Acquired with a Remidio FOP fundus camera. 1659 x 2212 pixels: 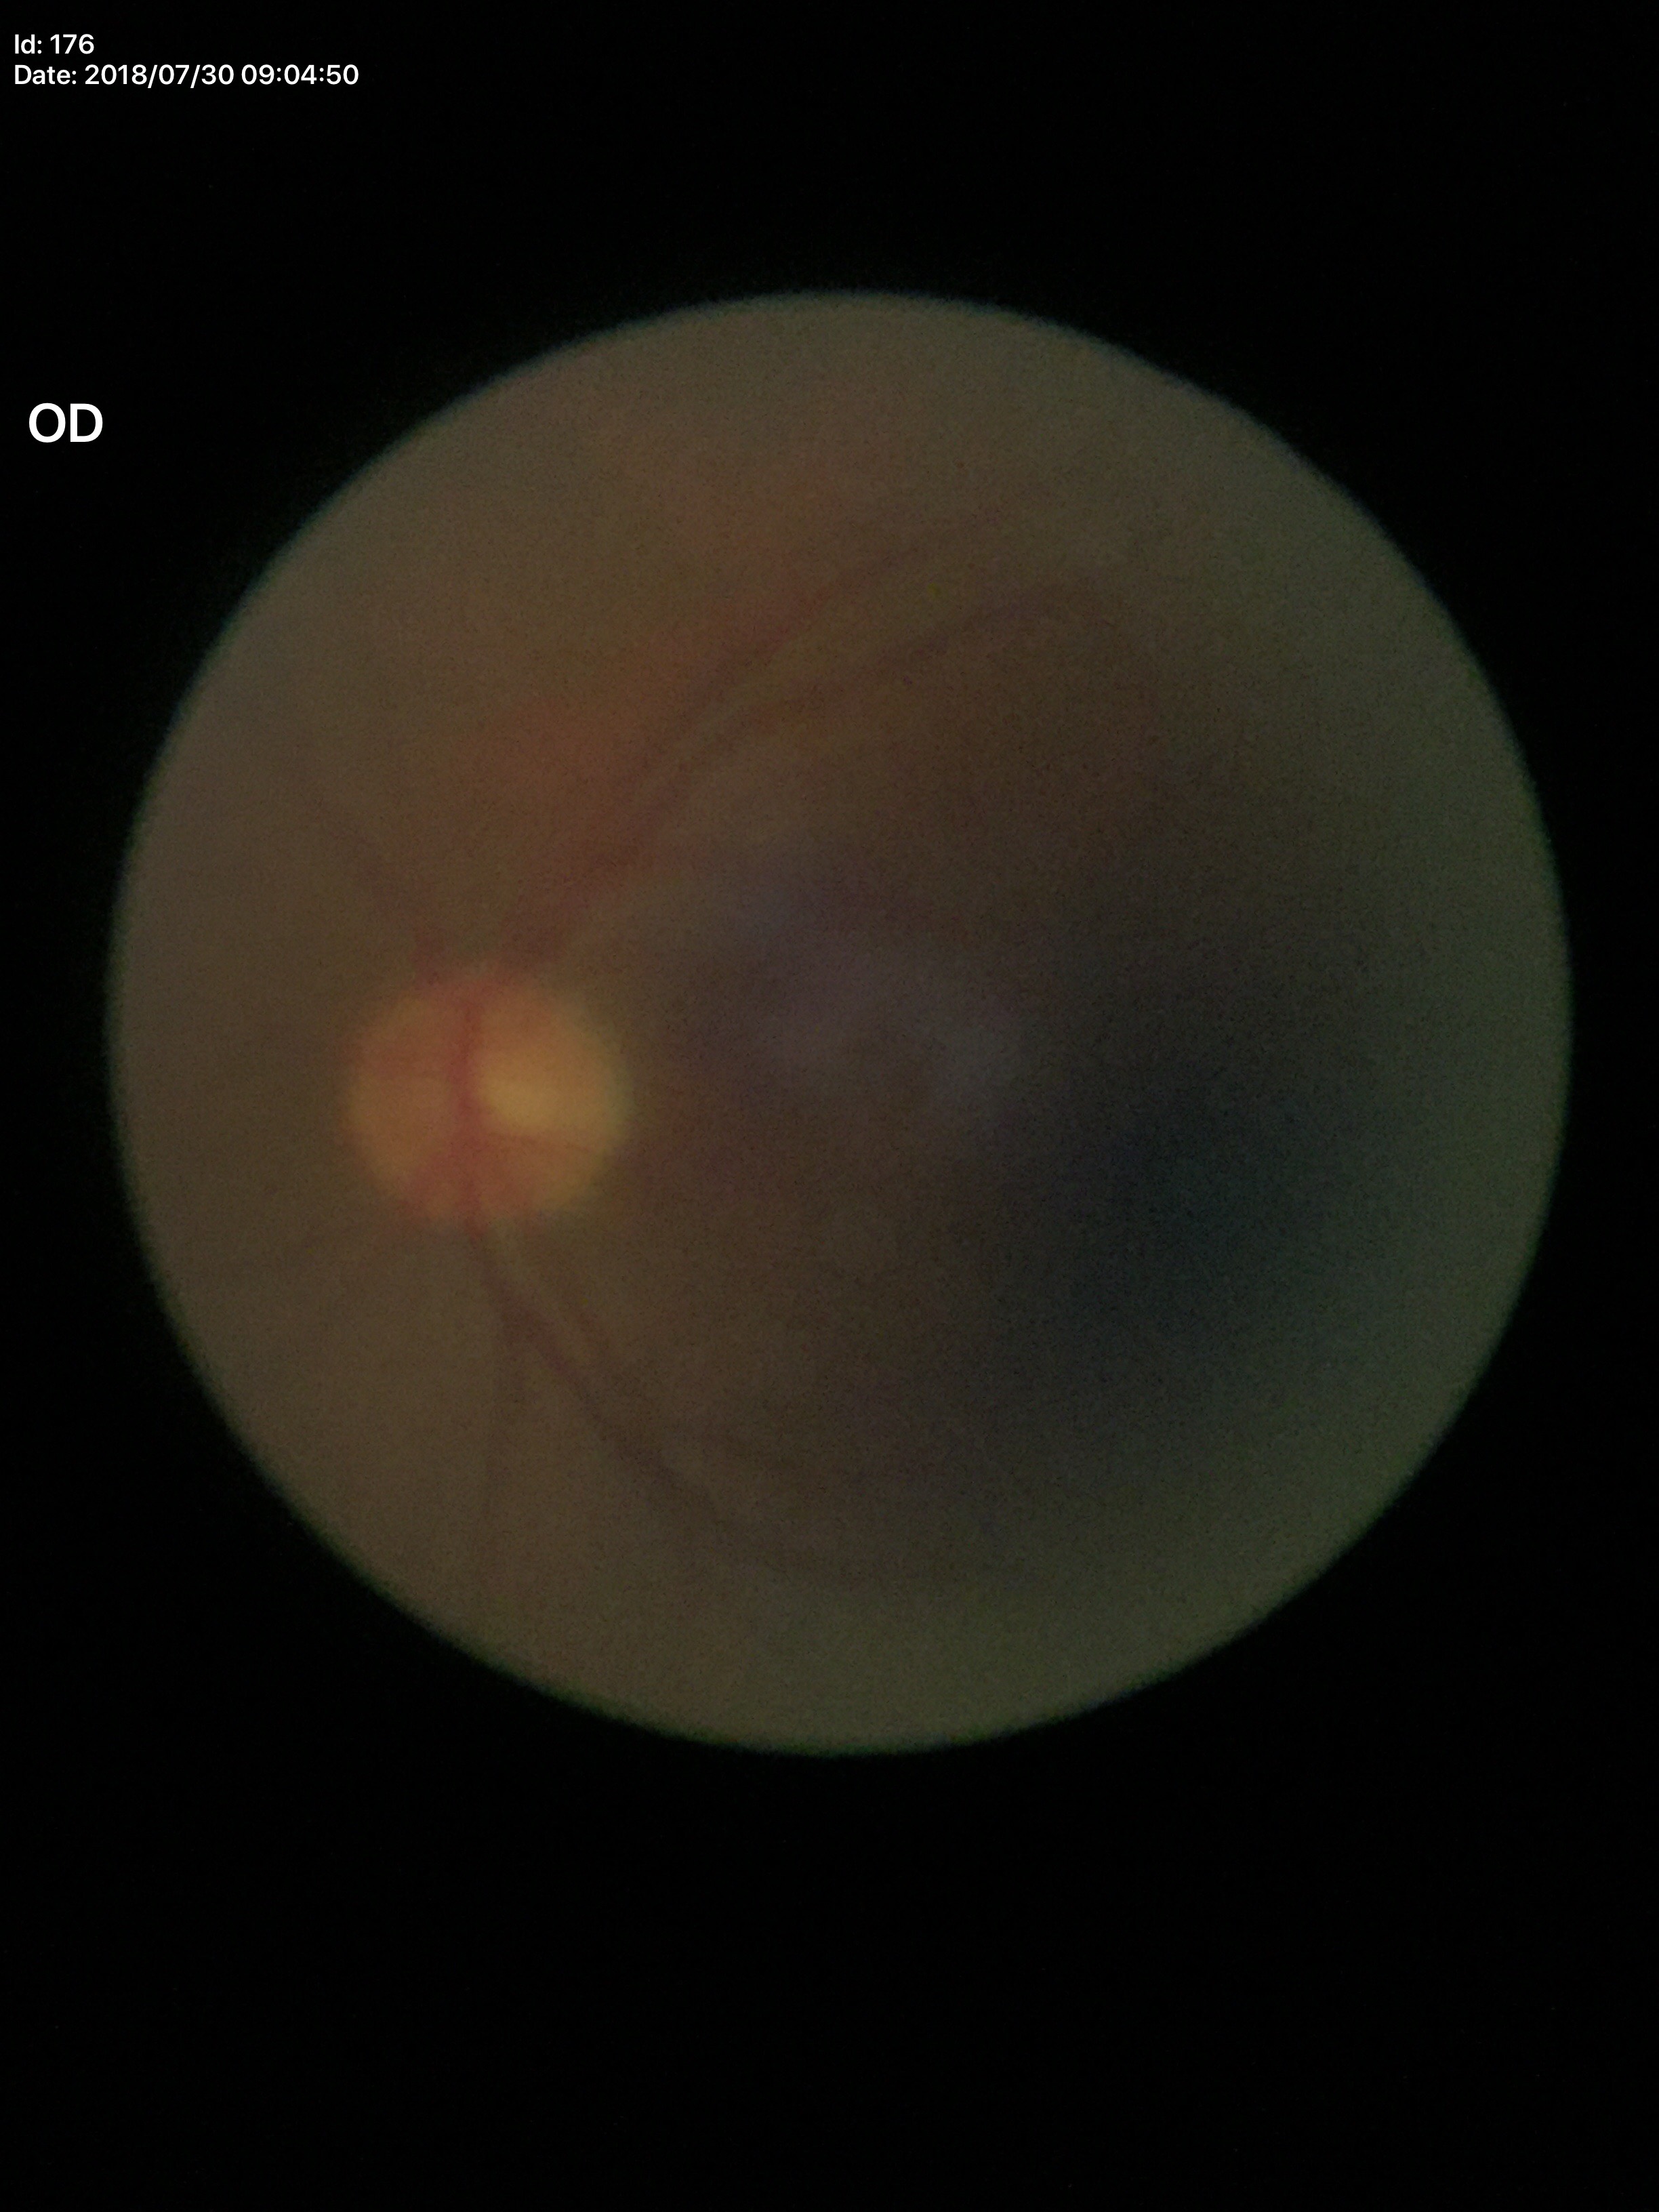

No evidence of glaucoma. Vertical cup-disc ratio of 0.42.